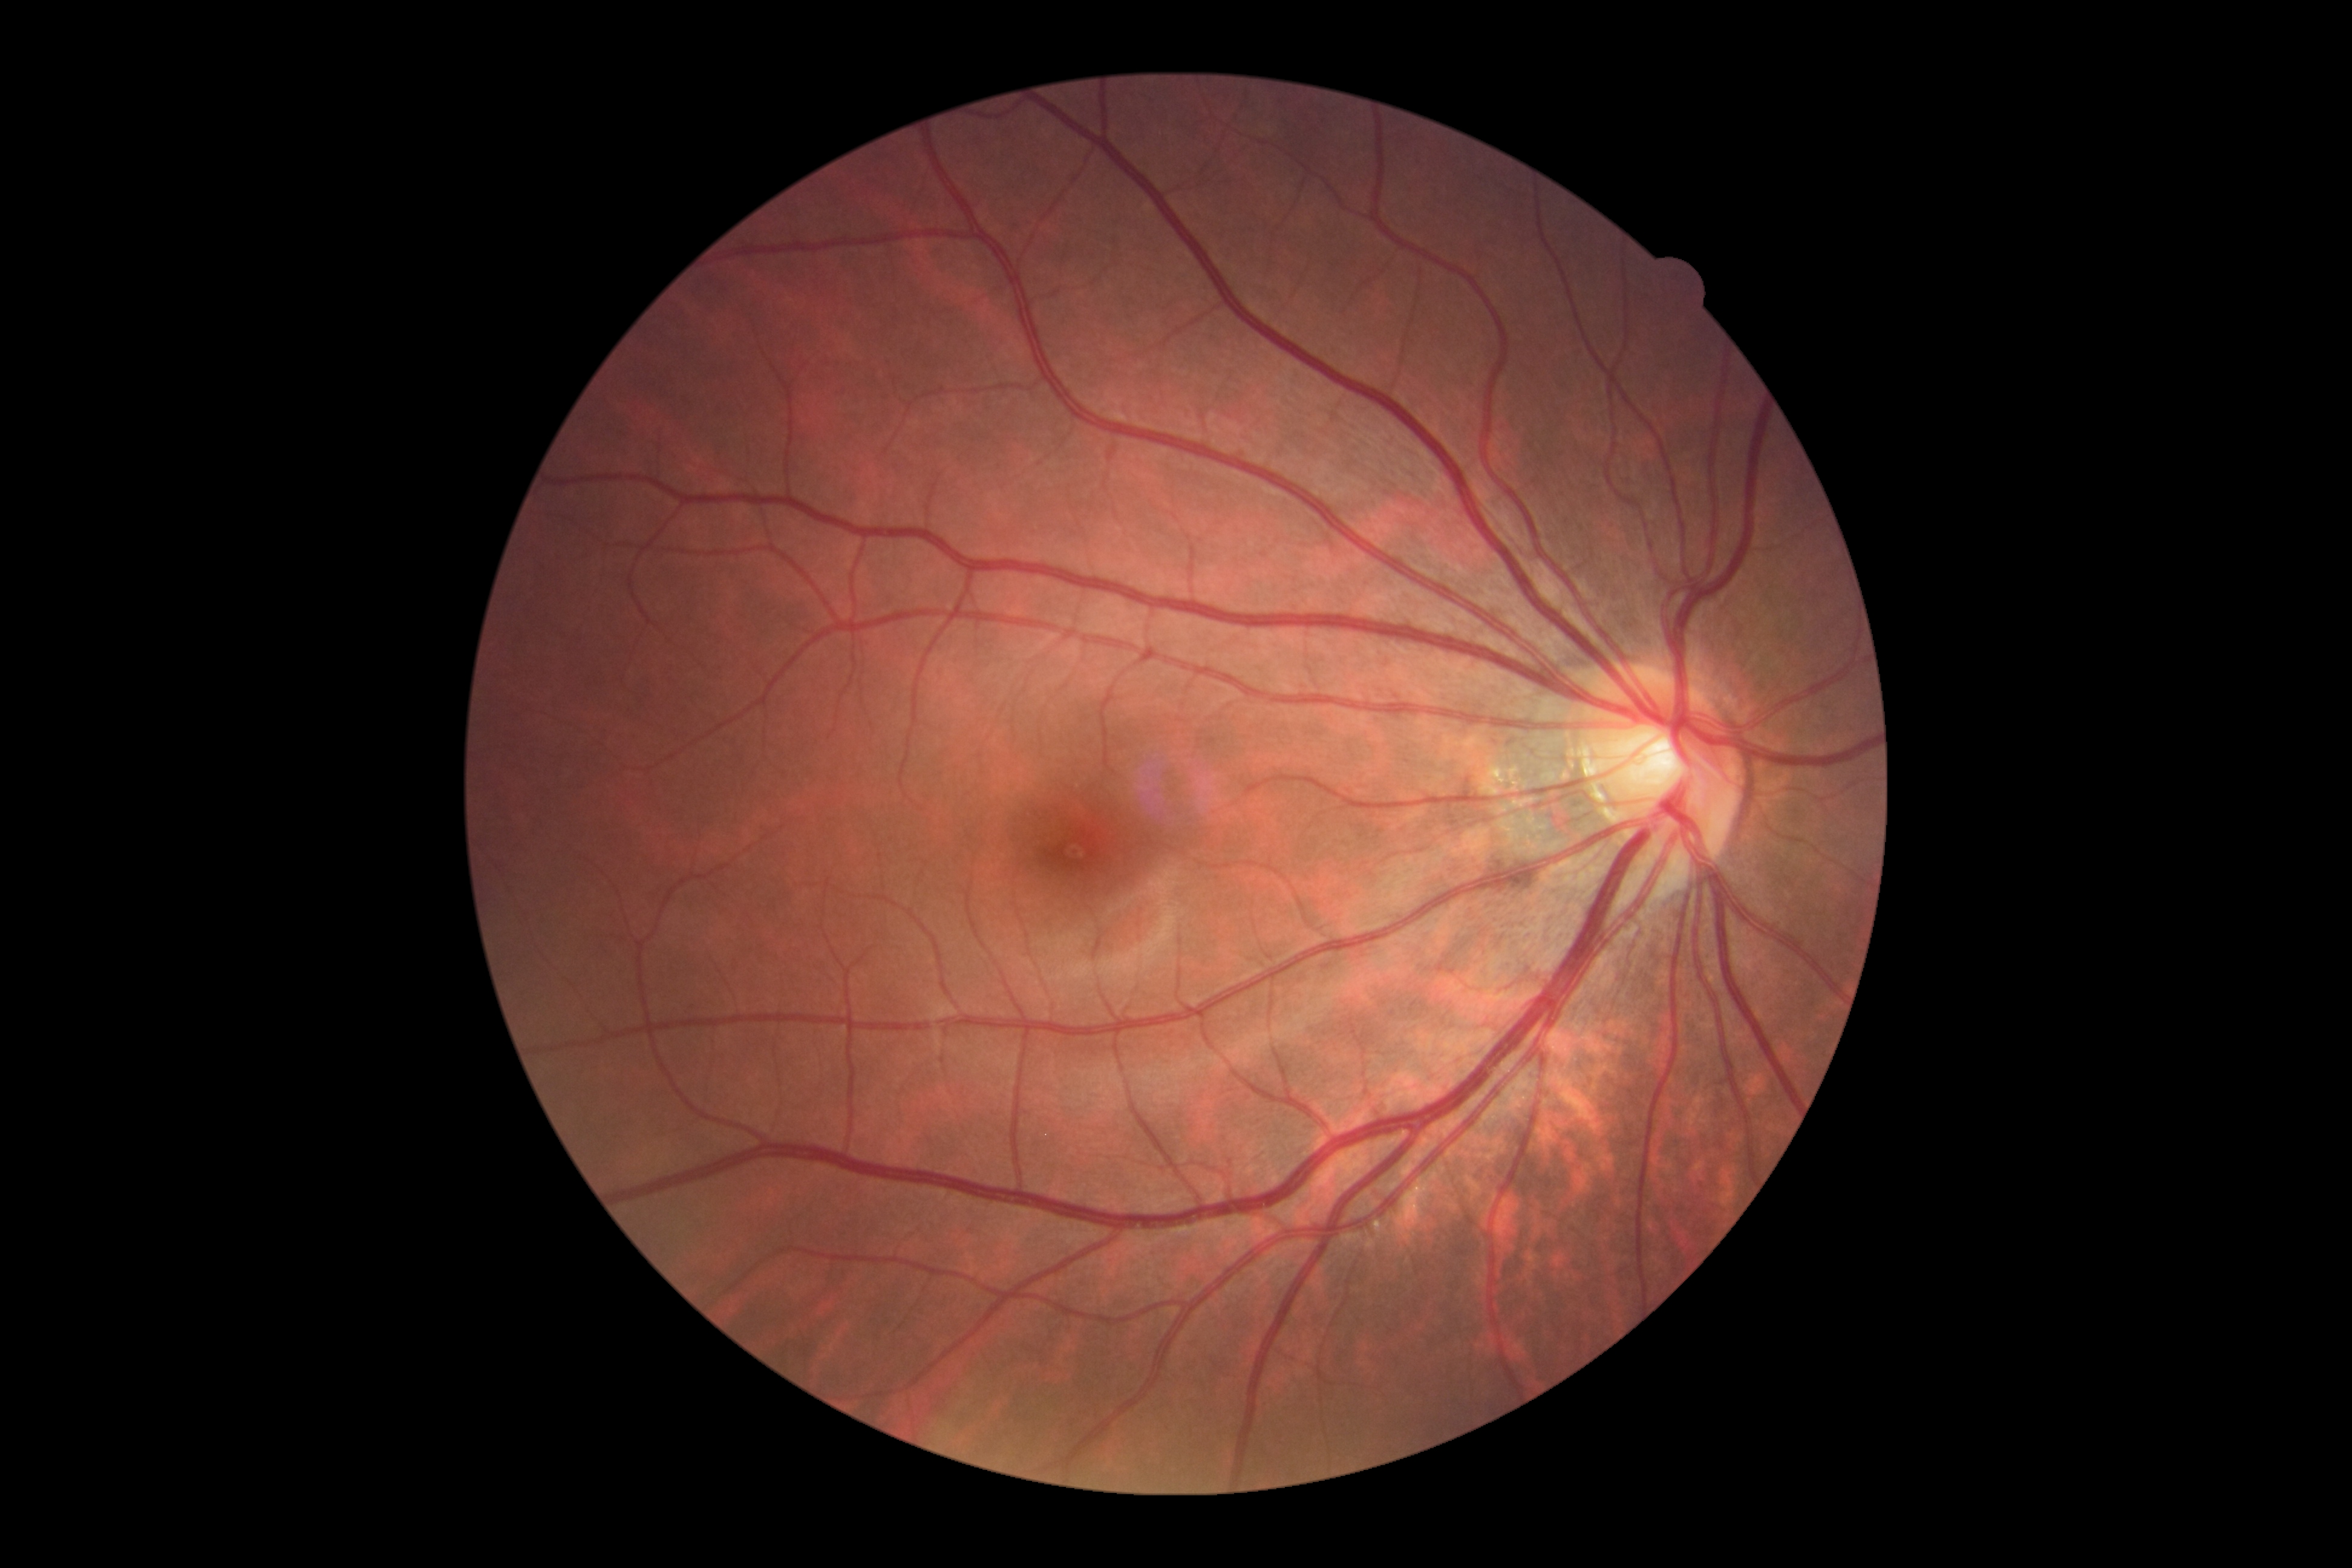 DR grade is no apparent diabetic retinopathy (0).